Posterior pole photograph, nonmydriatic fundus photograph, 45-degree field of view, acquired with a NIDEK AFC-230.
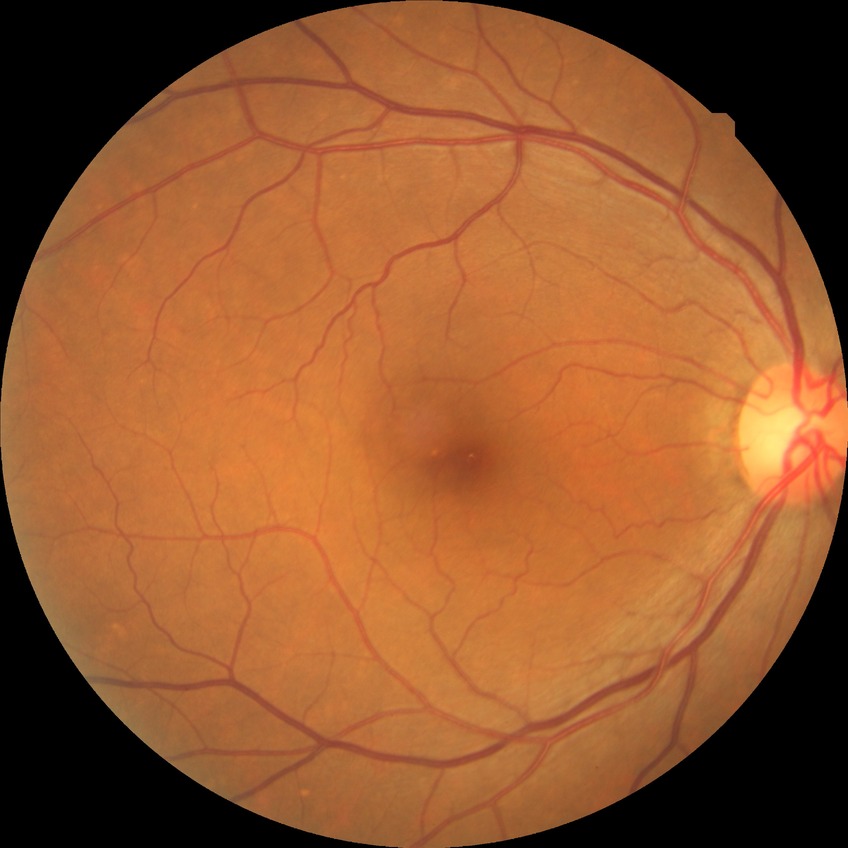 Diabetic retinopathy (DR): no diabetic retinopathy (NDR).